Without pupil dilation
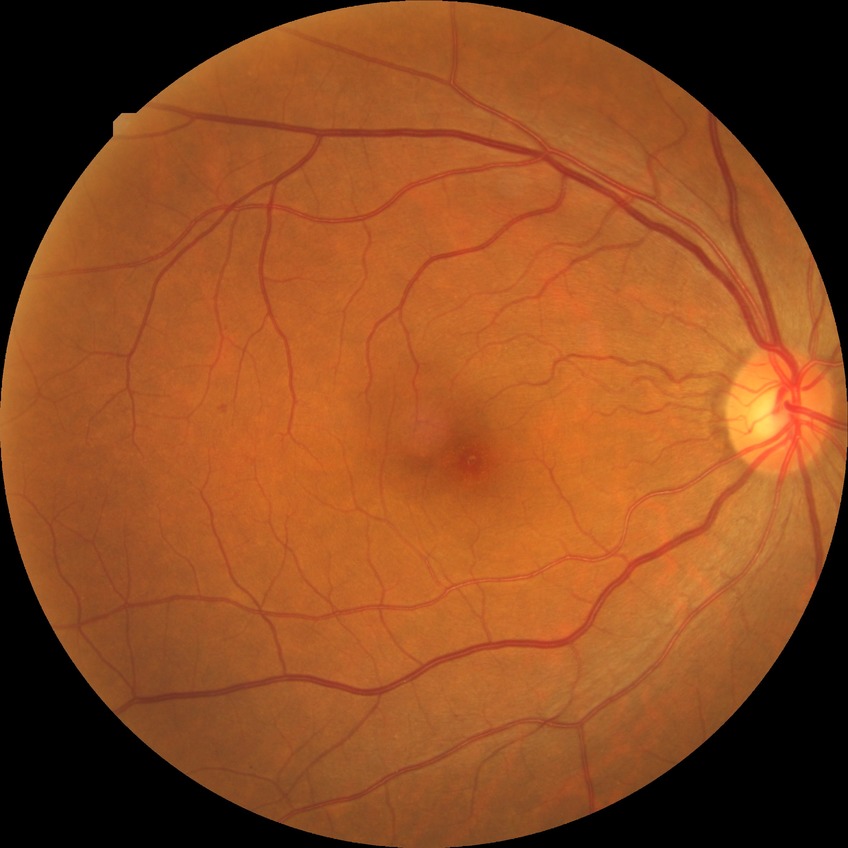 Davis grading is simple diabetic retinopathy.